Acquired with a Kowa VX-10α. 2361x1568
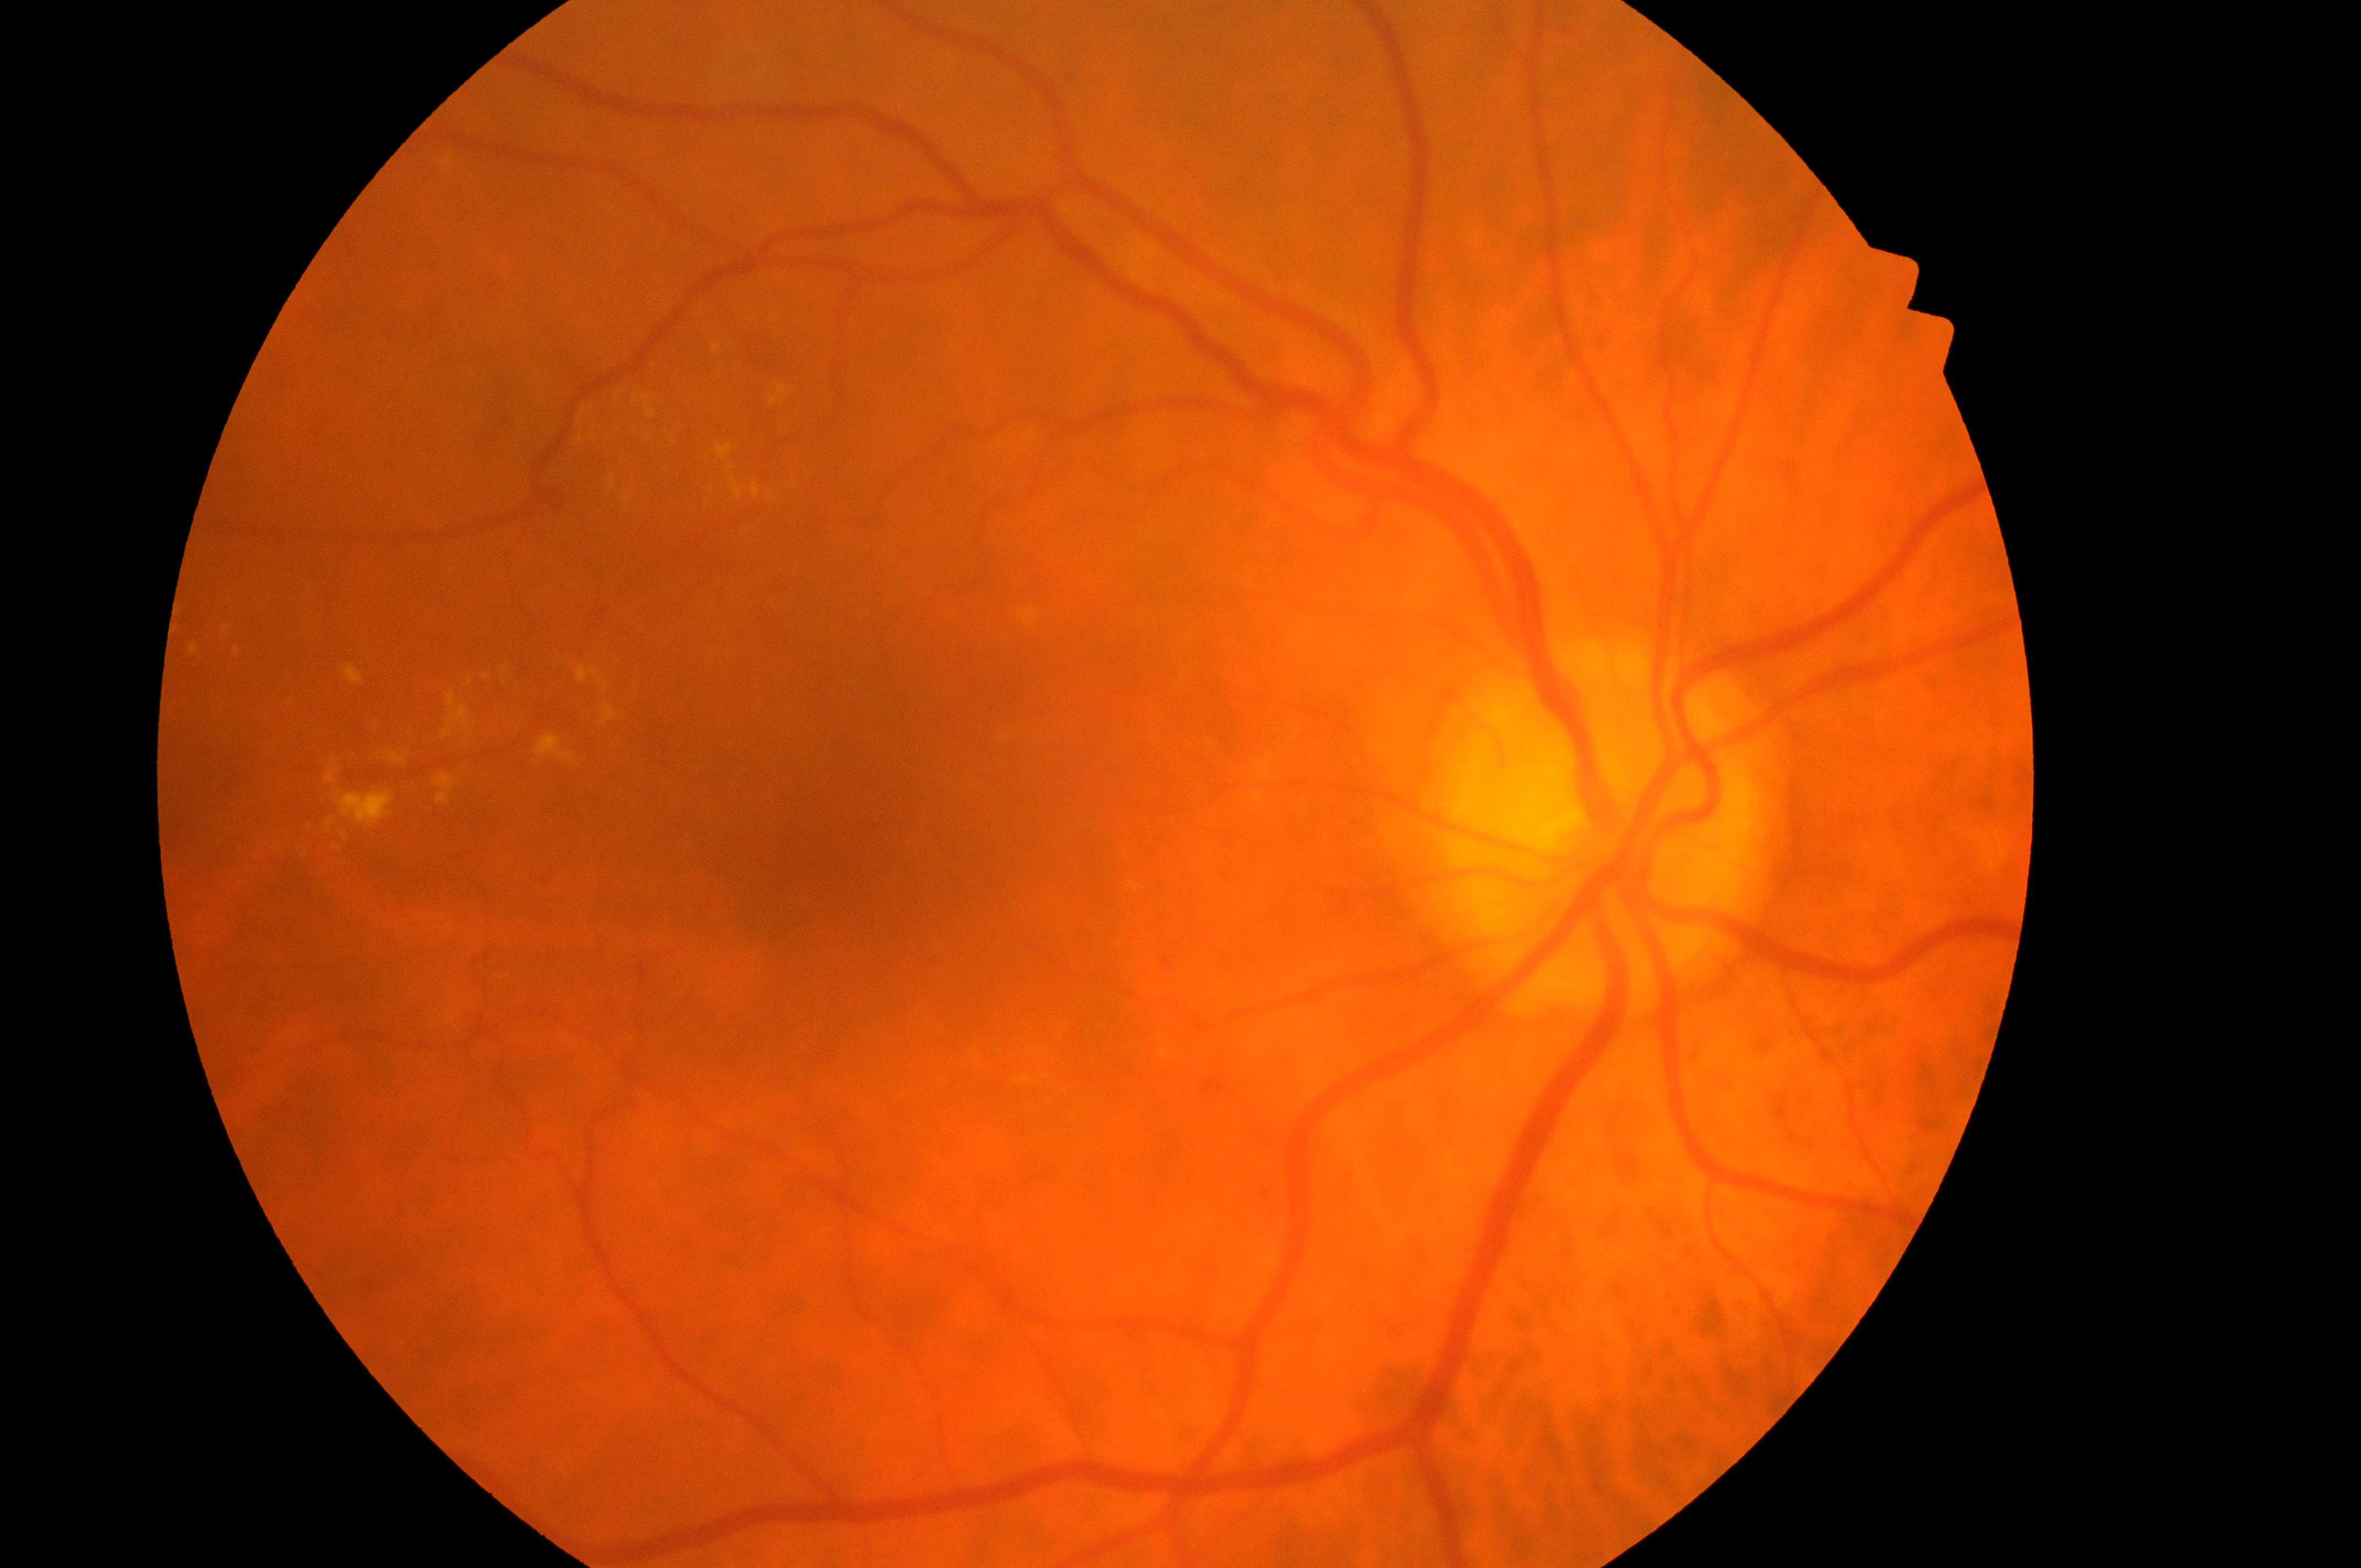
Annotations:
– DR grade — 2 (moderate NPDR) — more than just microaneurysms but less than severe NPDR
– the fovea — (x: 837, y: 872)
– laterality — right eye
– DME risk — grade 2 (high risk) — hard exudates within one disc diameter of the macula center
– ONH — (x: 1598, y: 856)